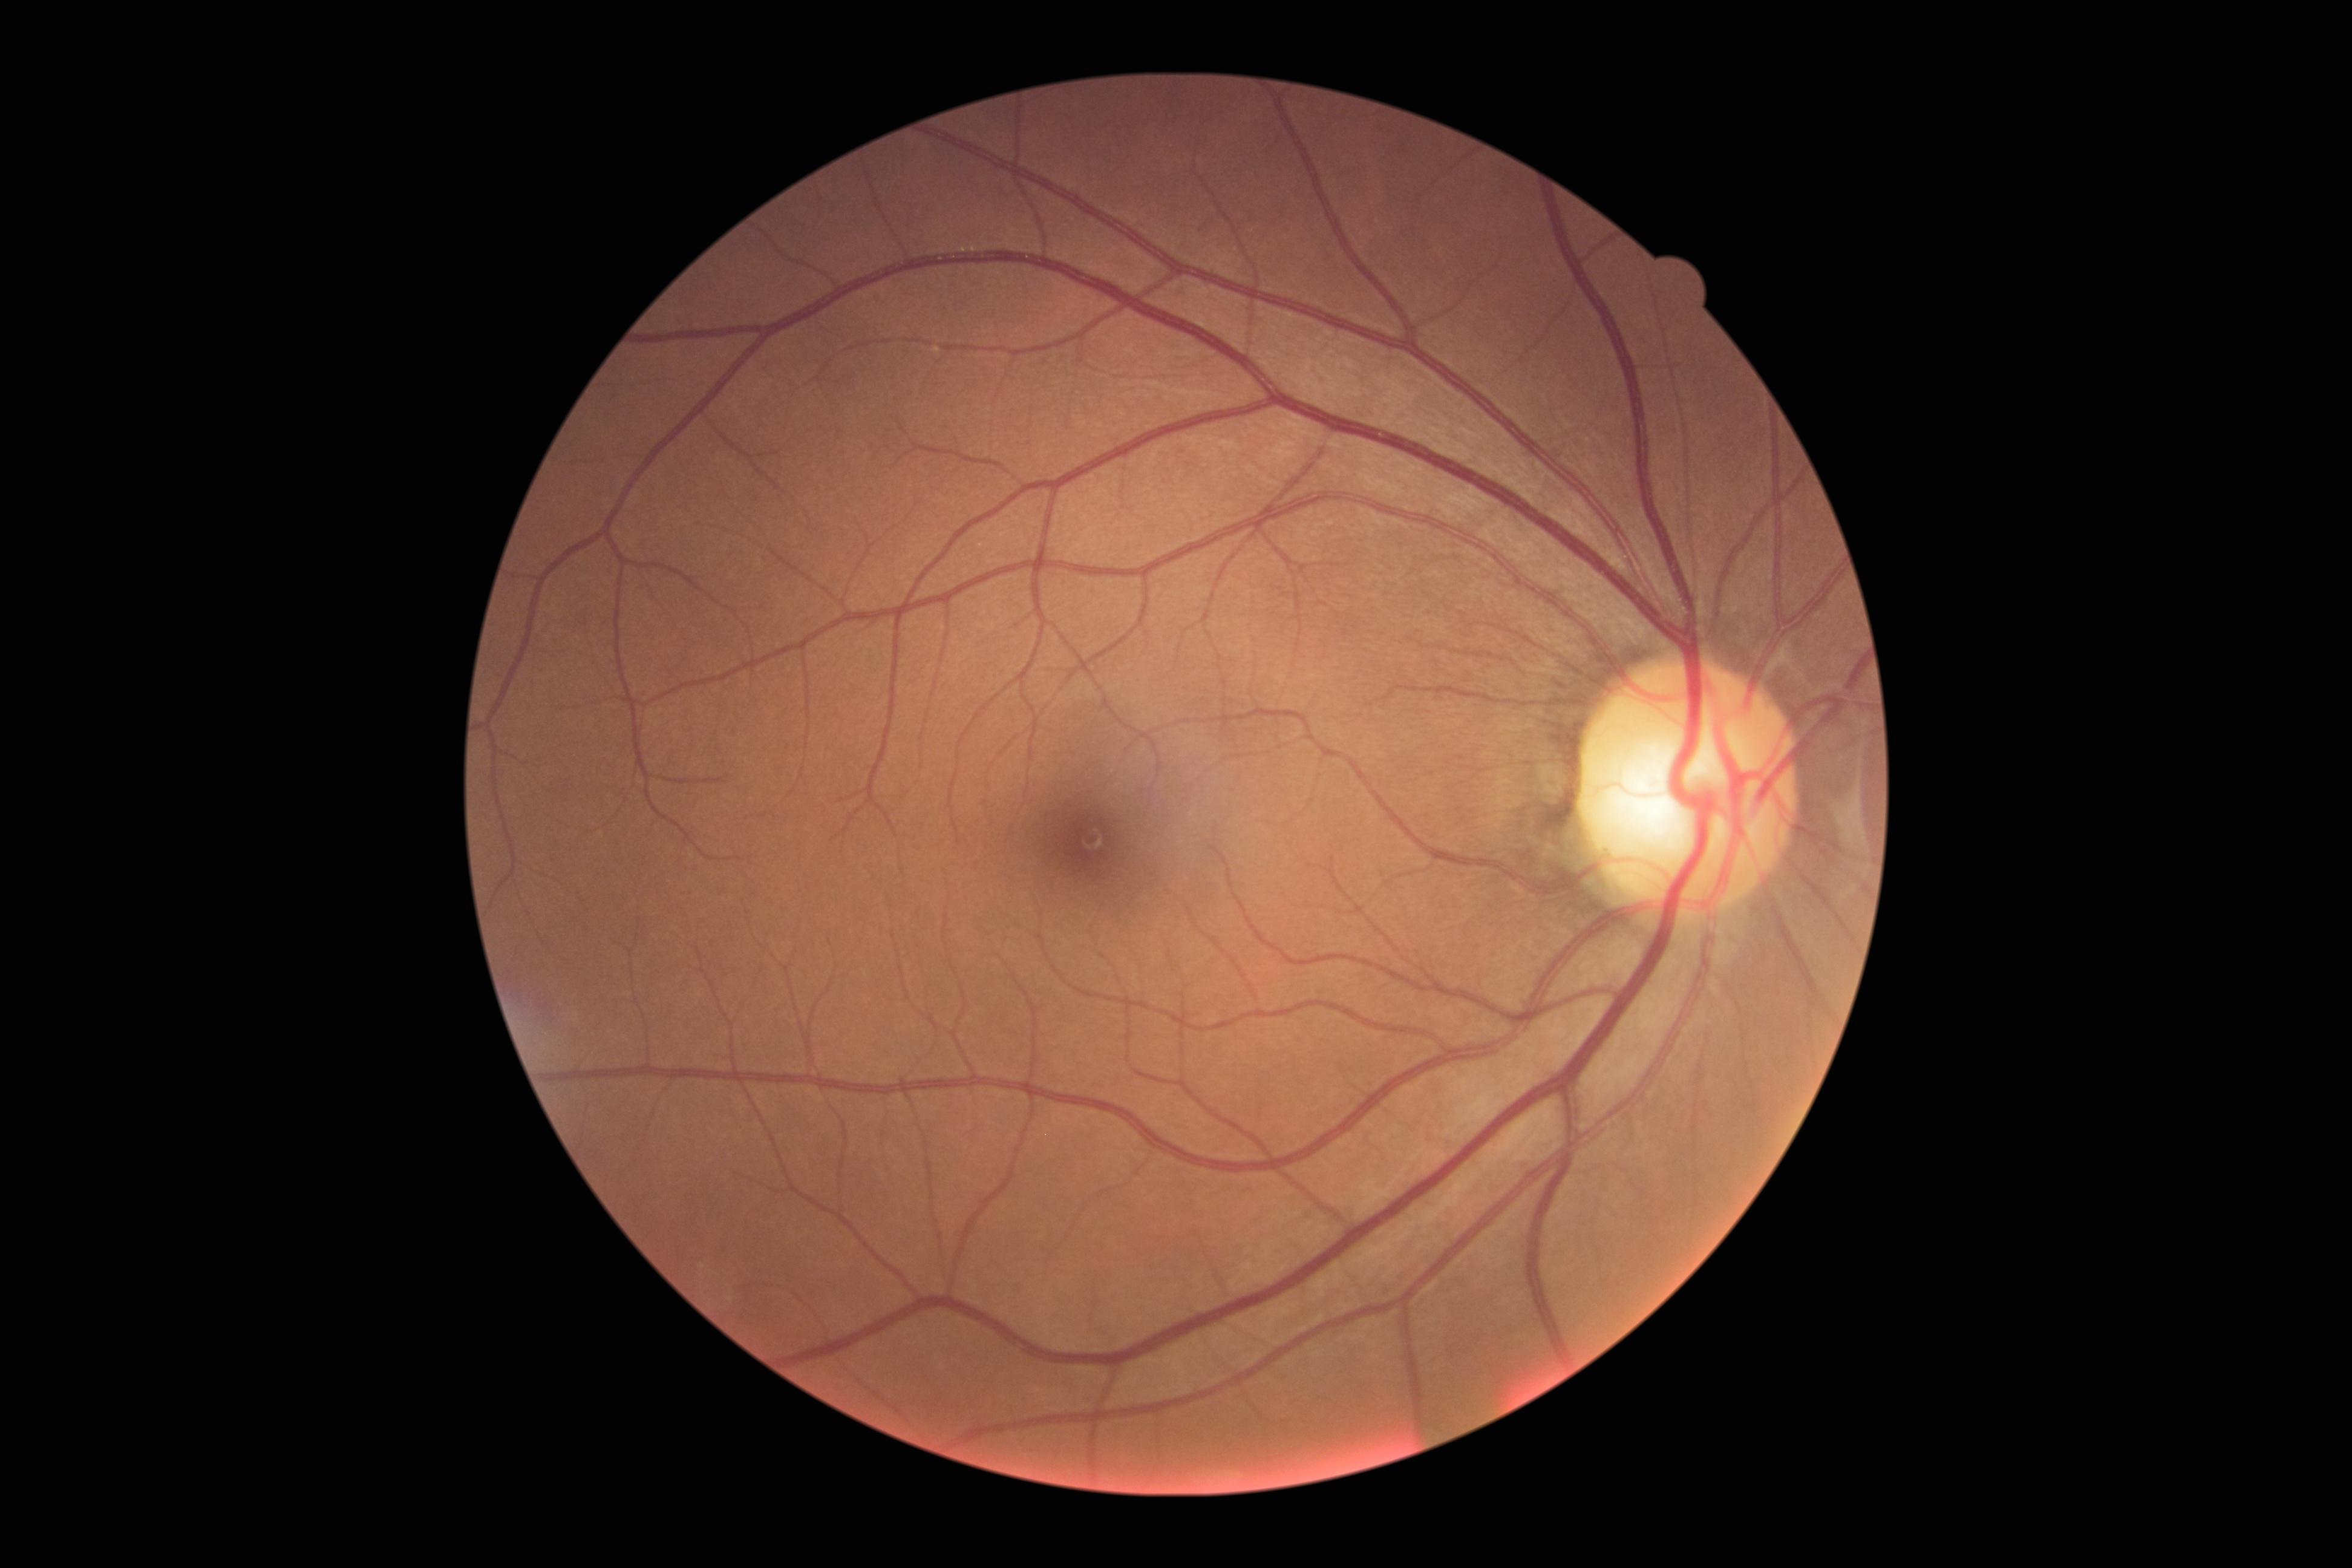

No diabetic retinal disease findings. DR is 0.